Color fundus image; 45 degree fundus photograph; camera: NIDEK AFC-230; nonmydriatic fundus photograph; Davis DR grading.
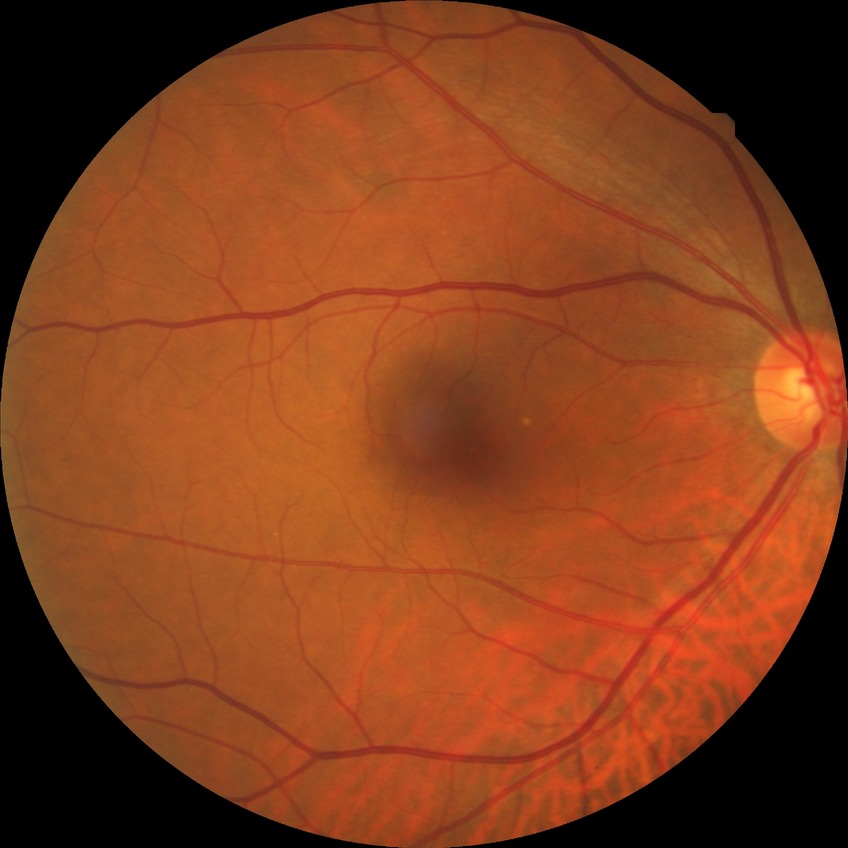

diabetic retinopathy (DR): NDR (no diabetic retinopathy).